Fundus photo. Image size 2352x1568.
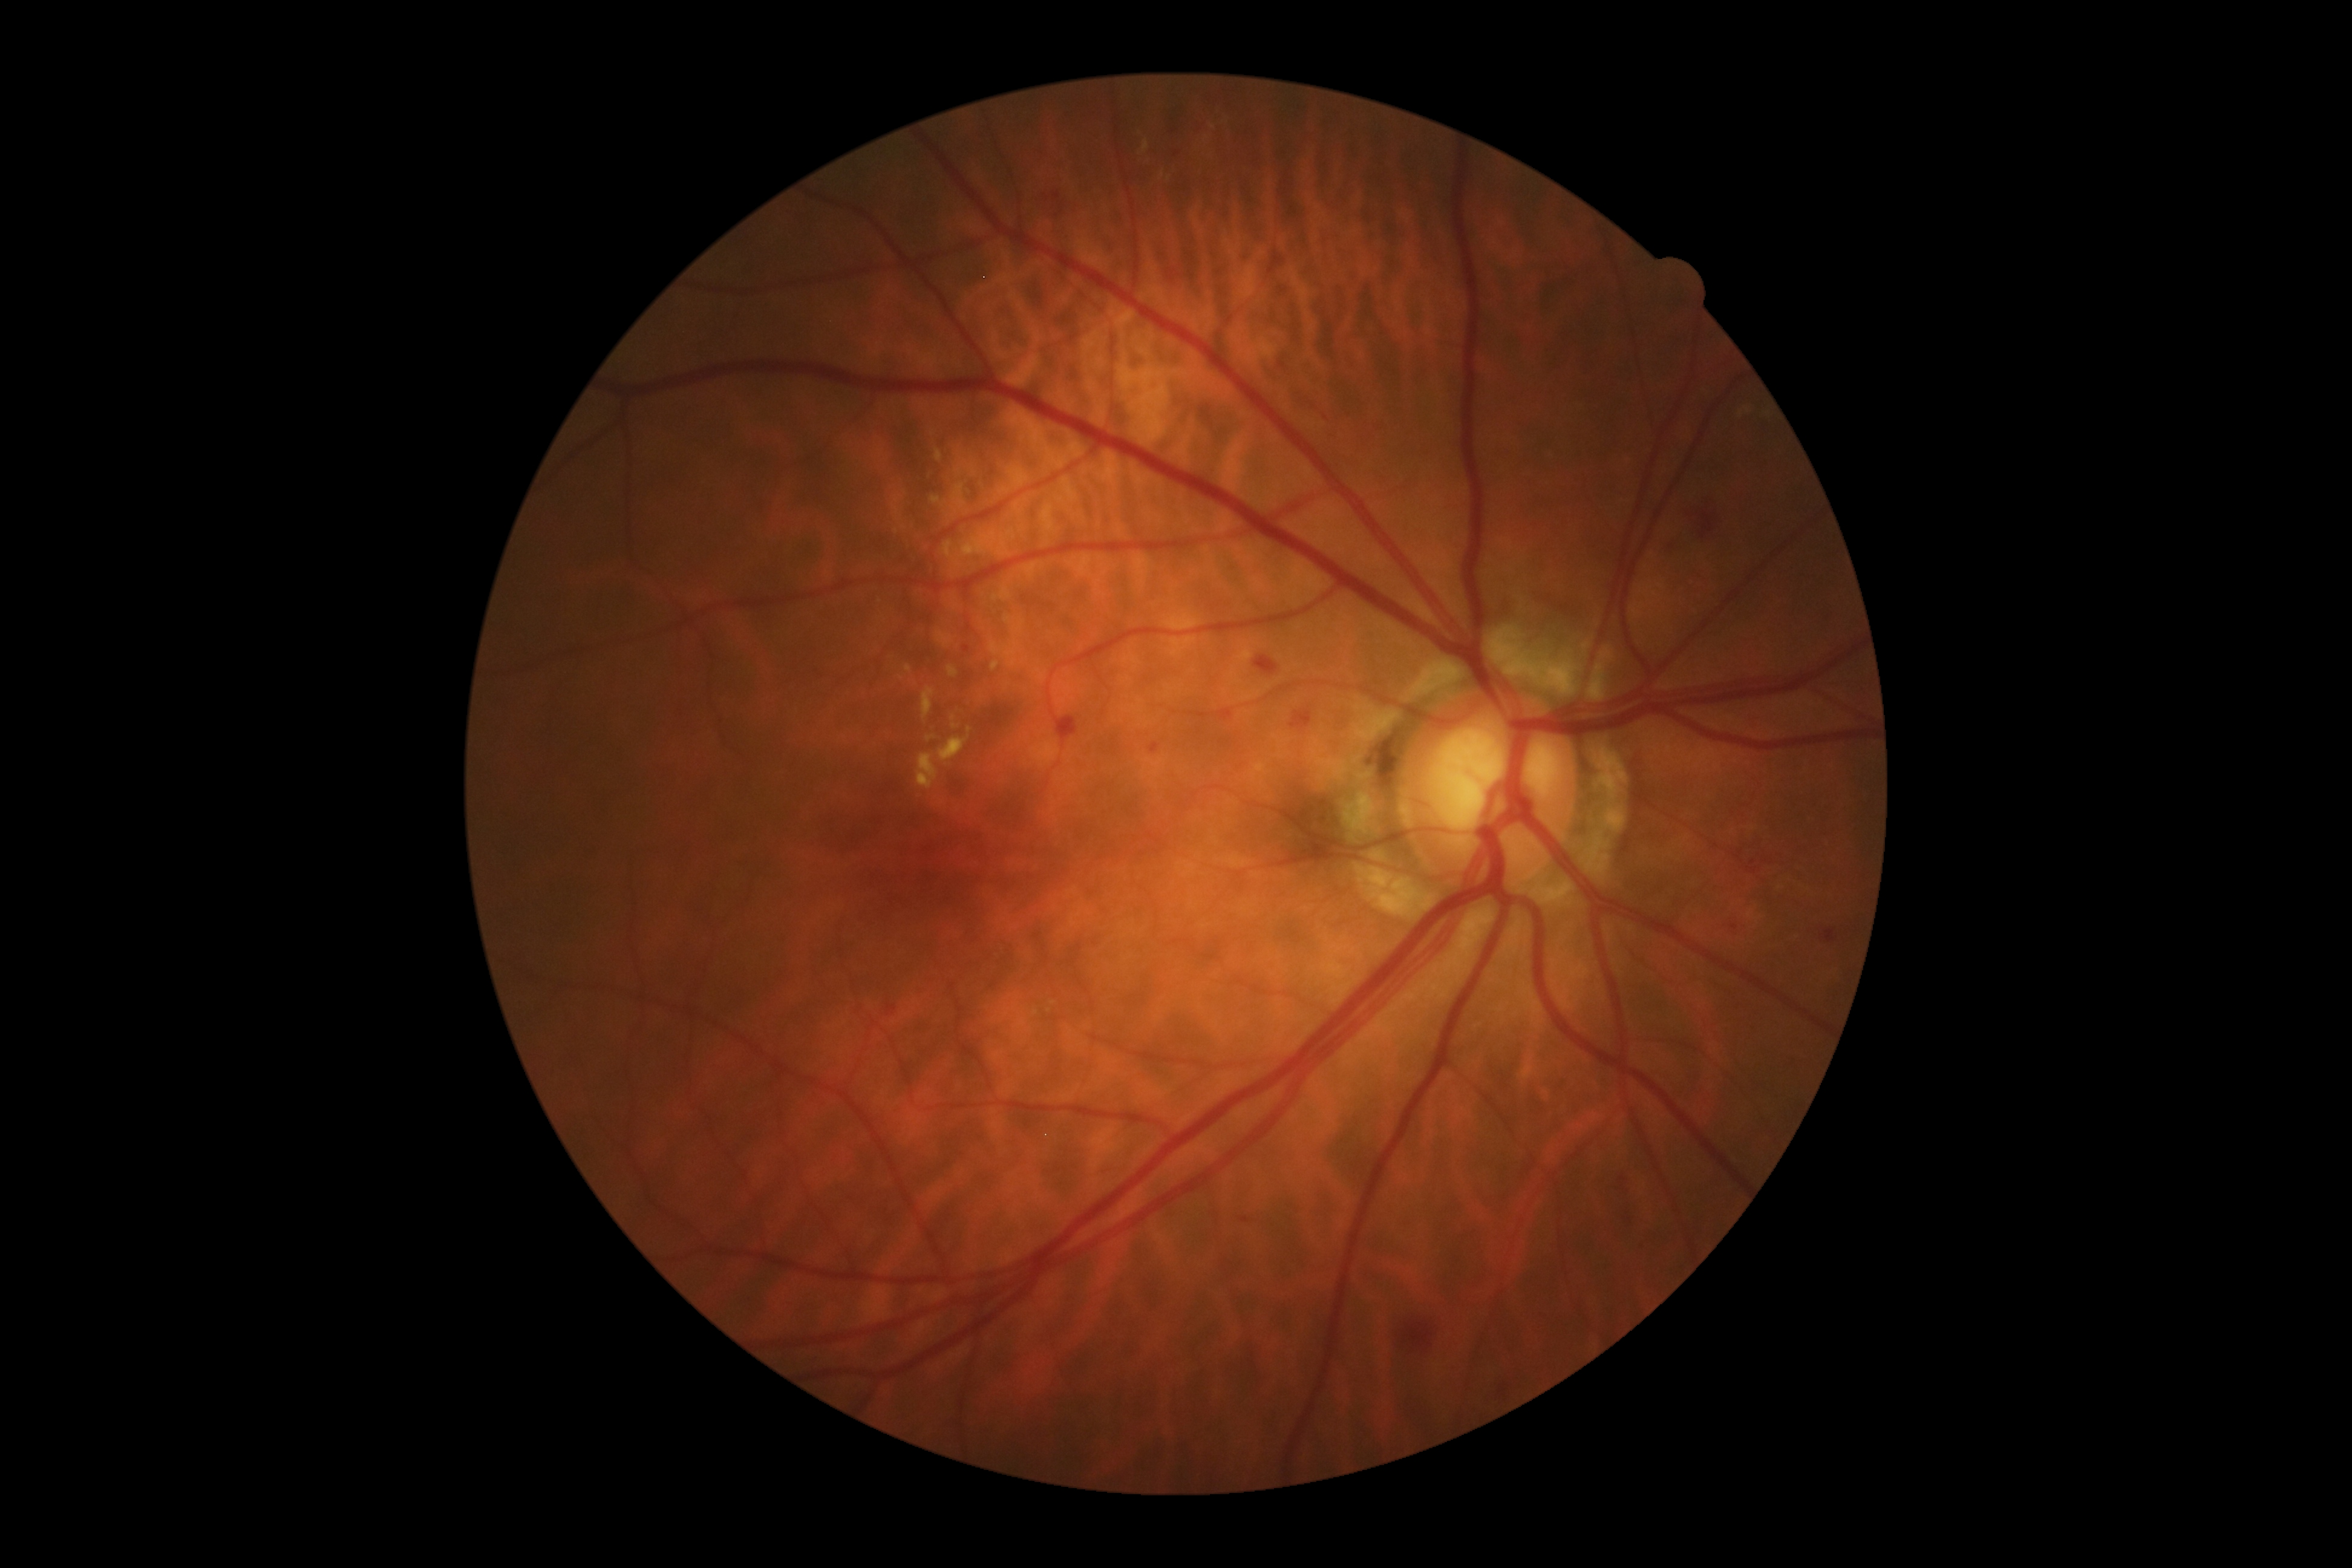
DR grade: moderate non-proliferative diabetic retinopathy (2)
Representative lesions:
- EXs (continued): 990,661,1001,671; 1024,564,1036,579; 921,688,935,719; 989,615,1025,668; 927,735,937,742; 904,666,912,672; 918,753,939,791; 999,488,1012,494; 936,631,953,649; 1033,668,1046,682
- Small EXs approximately at x=898 y=512; x=1036 y=1013; x=957 y=563; x=955 y=606
- SEs: none identified
- MAs: 1731,923,1738,931; 1821,929,1836,944; 962,647,970,653; 1618,1177,1628,1184; 1150,743,1160,753; 1218,708,1232,722; 1240,1217,1250,1224
- Small MAs approximately at x=1177 y=154
- HEs: 1254,656,1278,677; 1290,707,1312,733; 1053,192,1062,203; 1054,717,1077,742; 1059,203,1064,214; 1698,511,1715,539; 1404,1322,1433,1348
- Small HEs approximately at x=1048 y=198